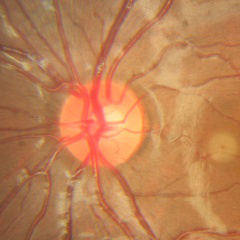

Demonstrates no glaucomatous findings.